CFP: 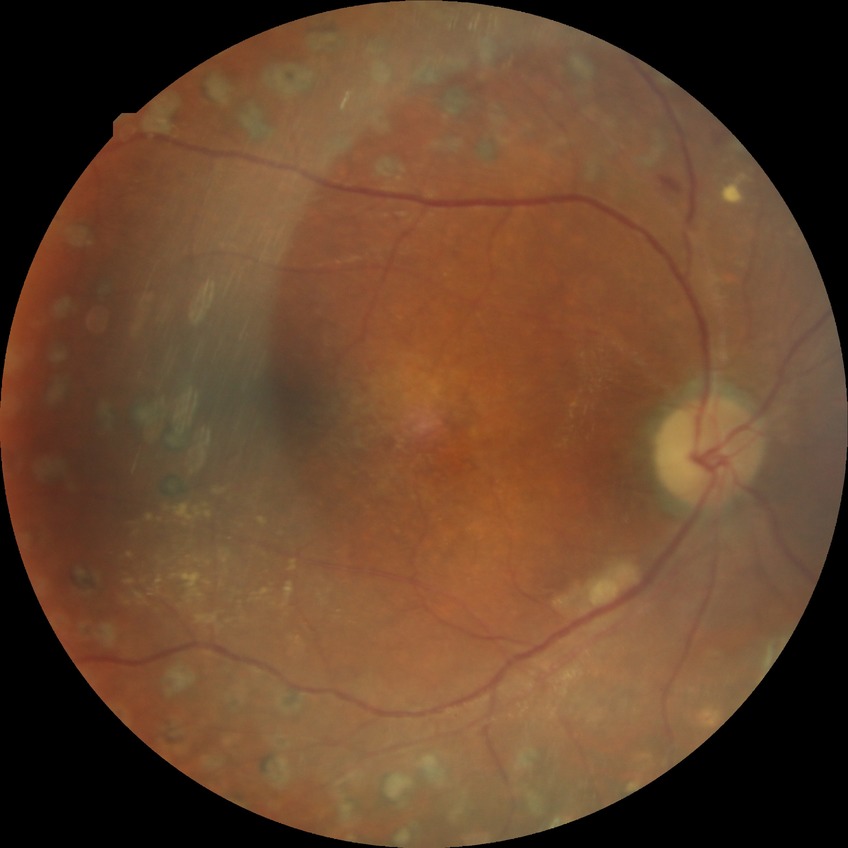

davis_grade: PDR